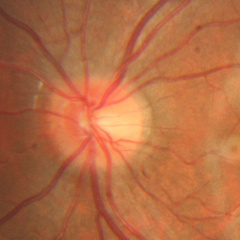 No glaucomatous findings.